2352 by 1568 pixels: 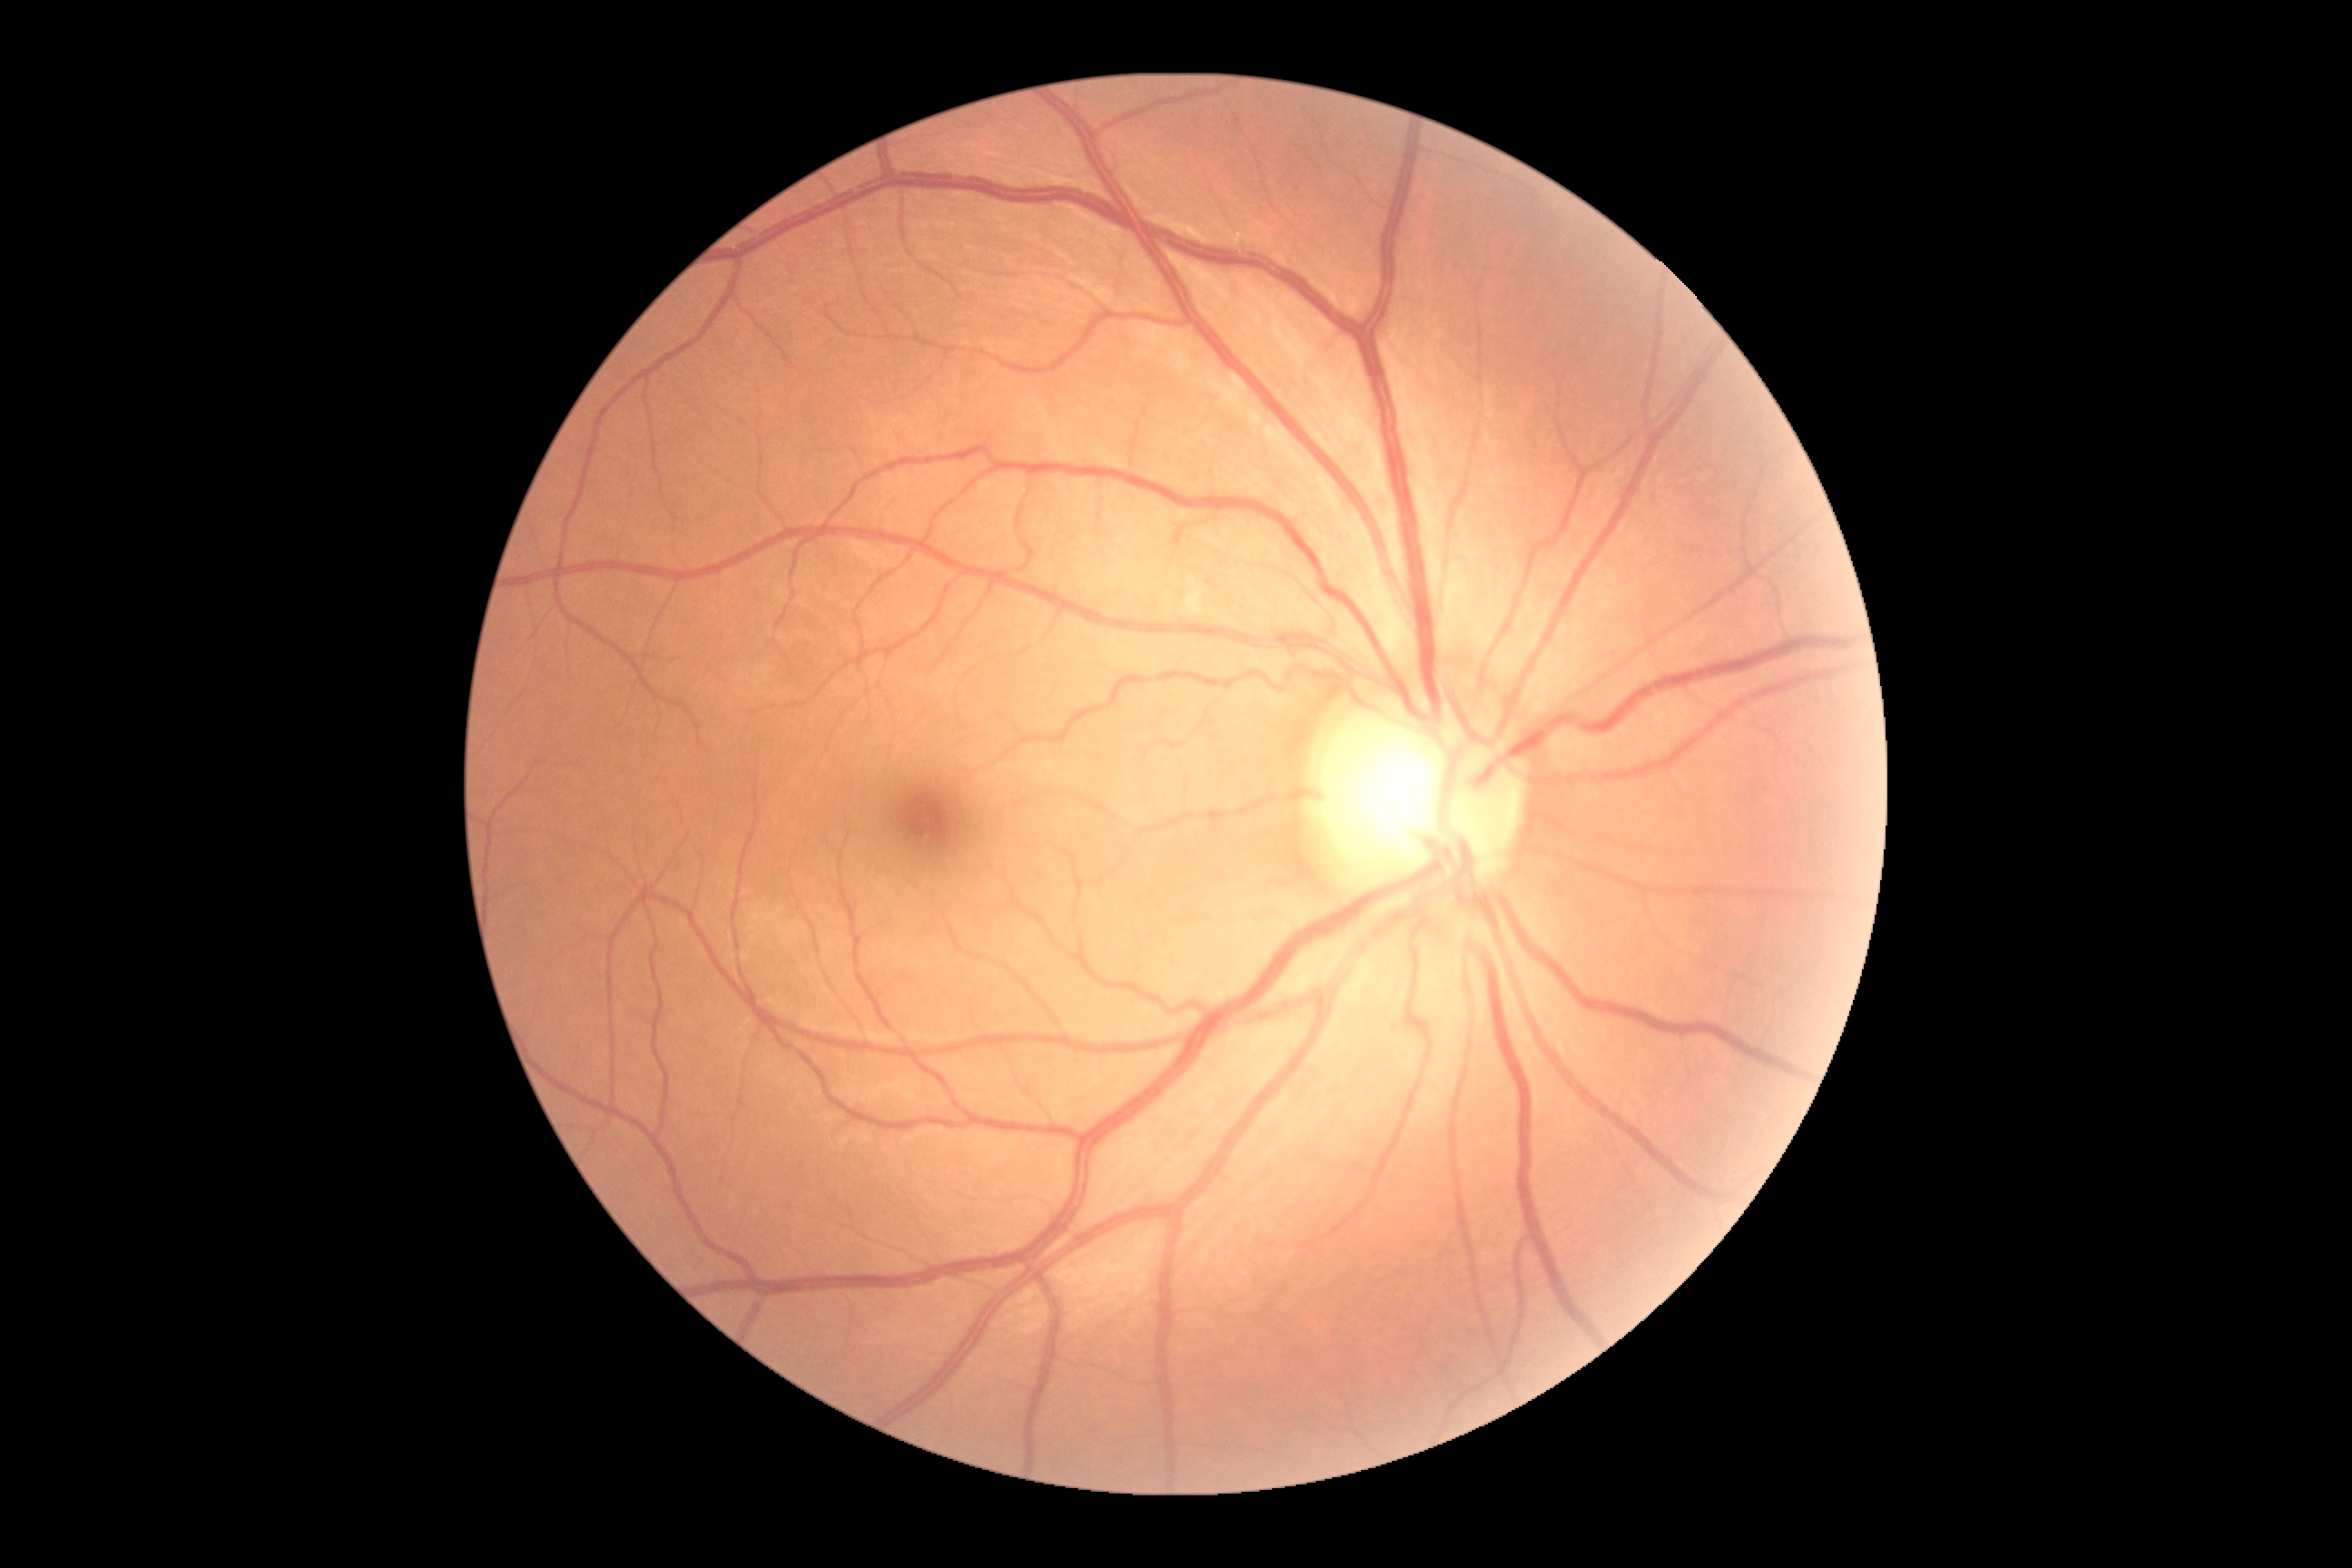 {
  "dr_grade": "no apparent diabetic retinopathy (grade 0)"
}